45° FOV. 2352 x 1568 pixels: 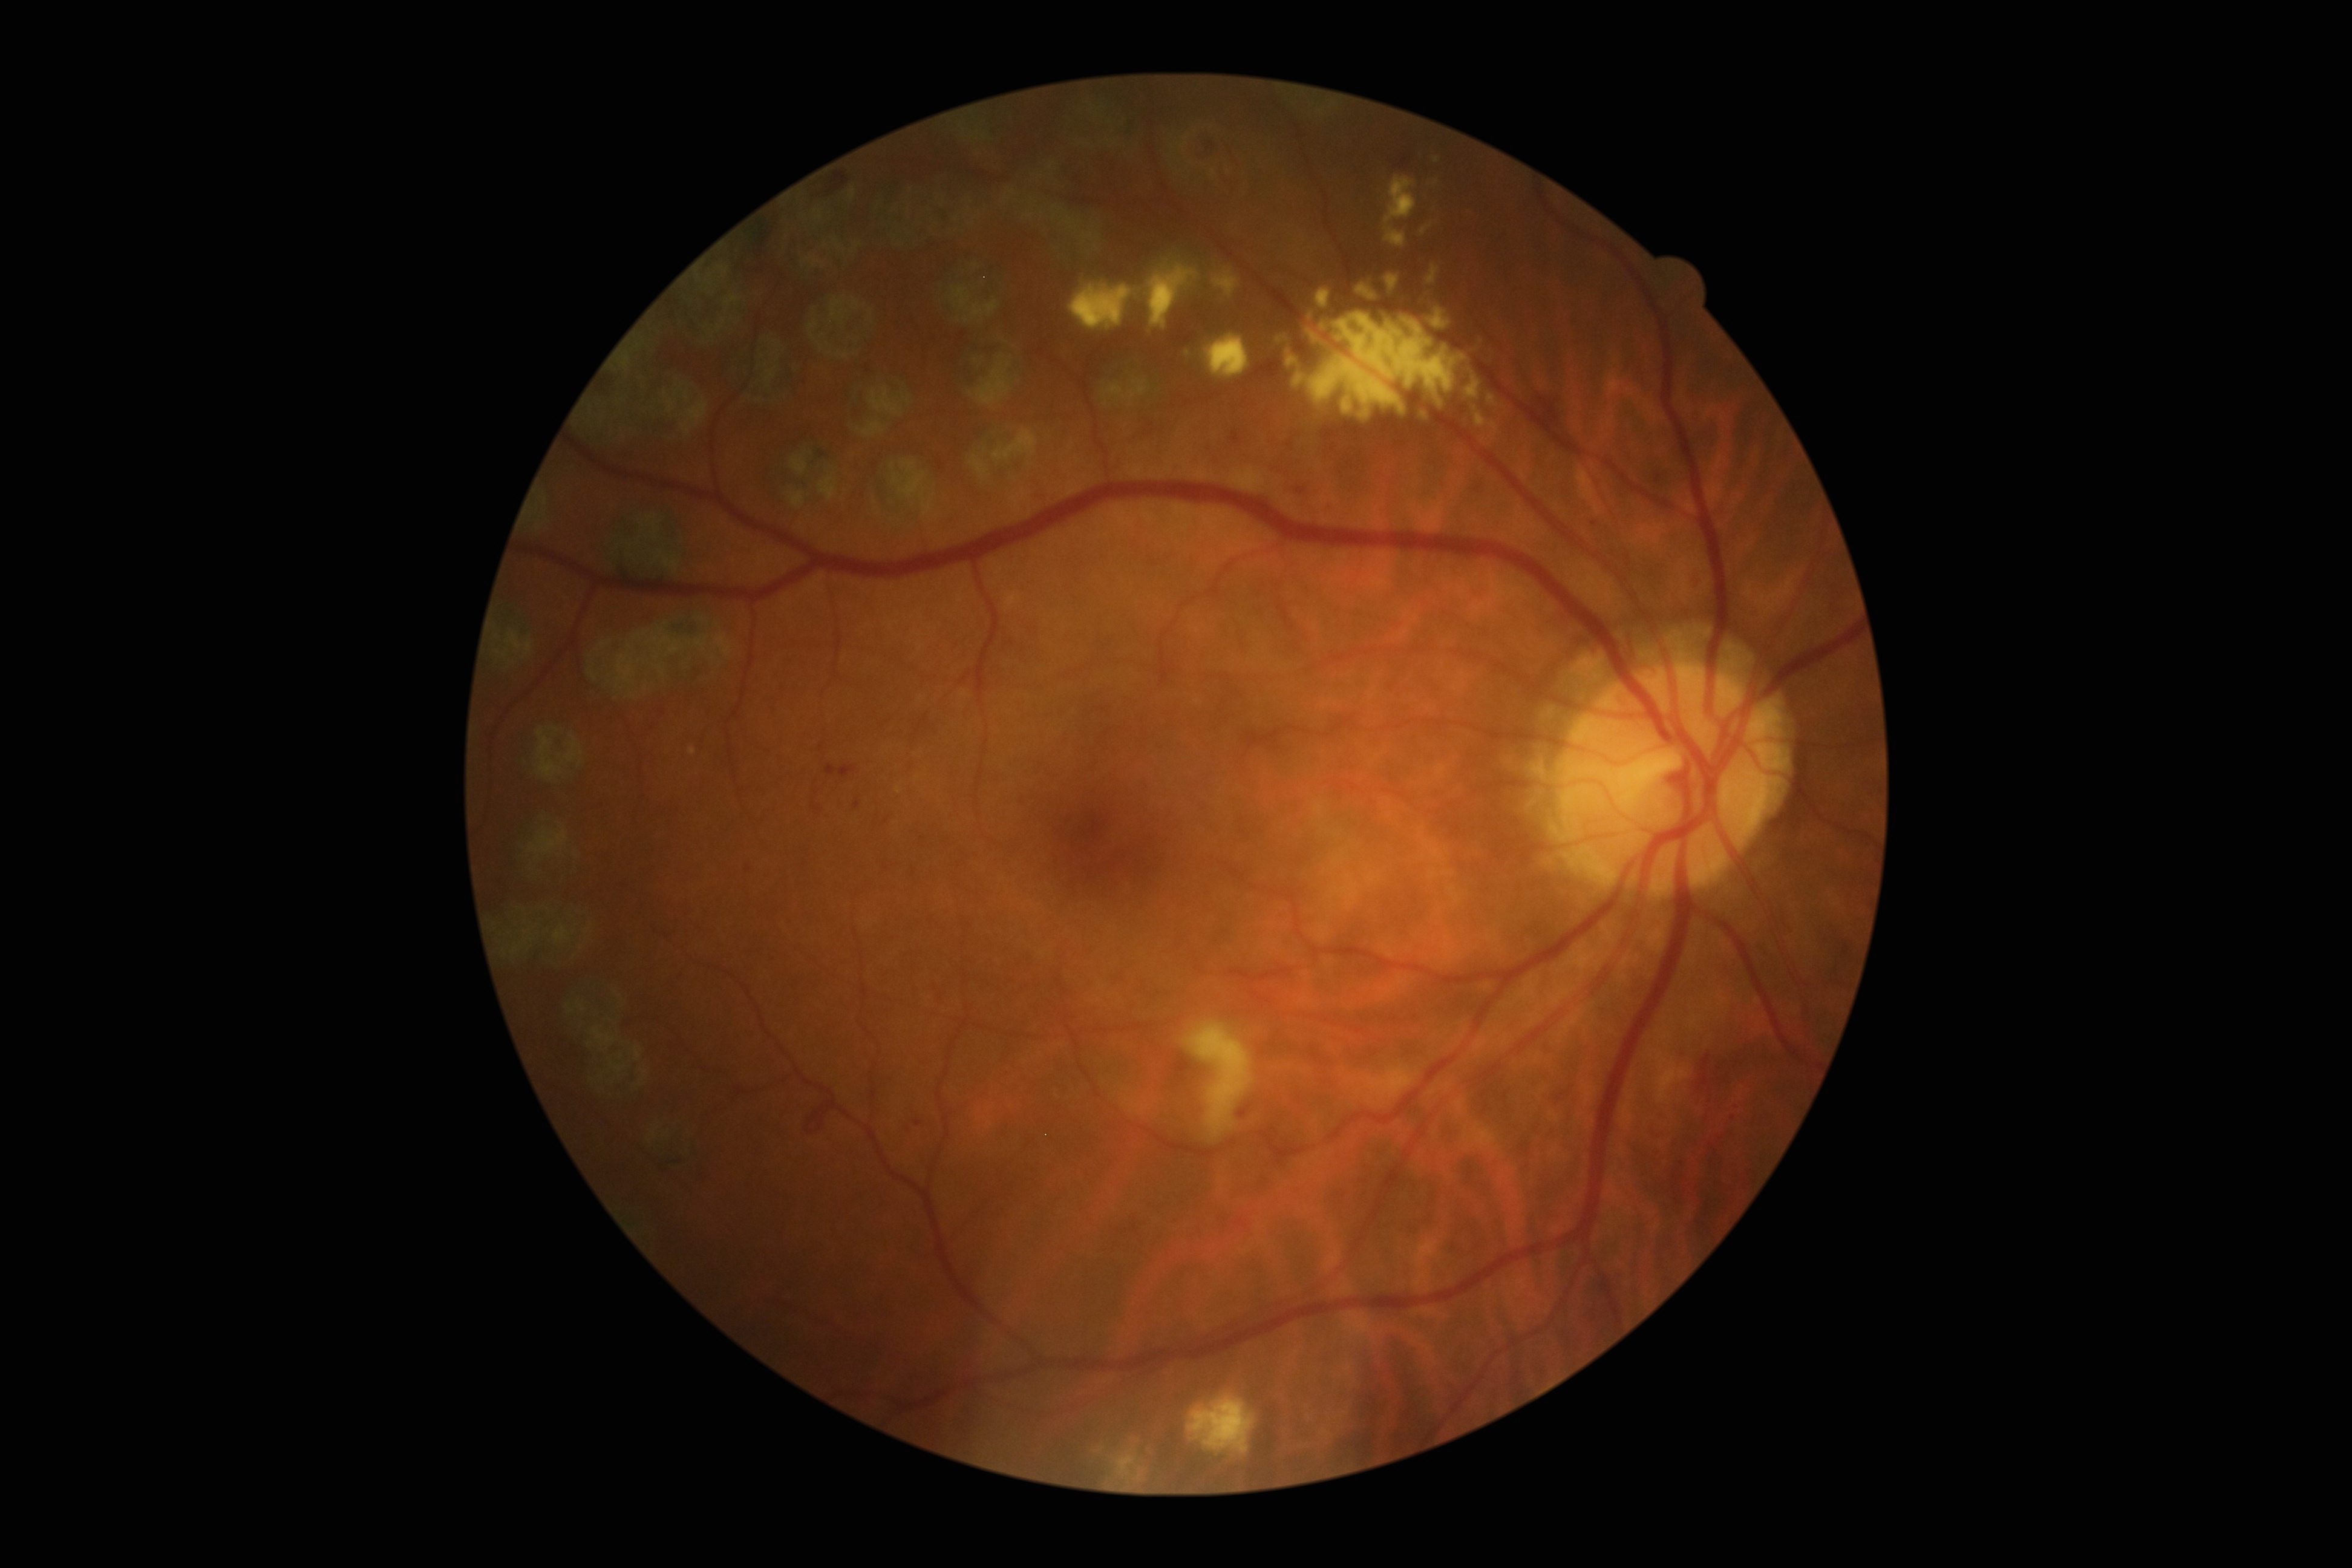

Findings:
* diabetic retinopathy severity — grade 2 (moderate NPDR)
* DR class — non-proliferative diabetic retinopathy